Color fundus photograph from a handheld portable camera. 2212x1659: 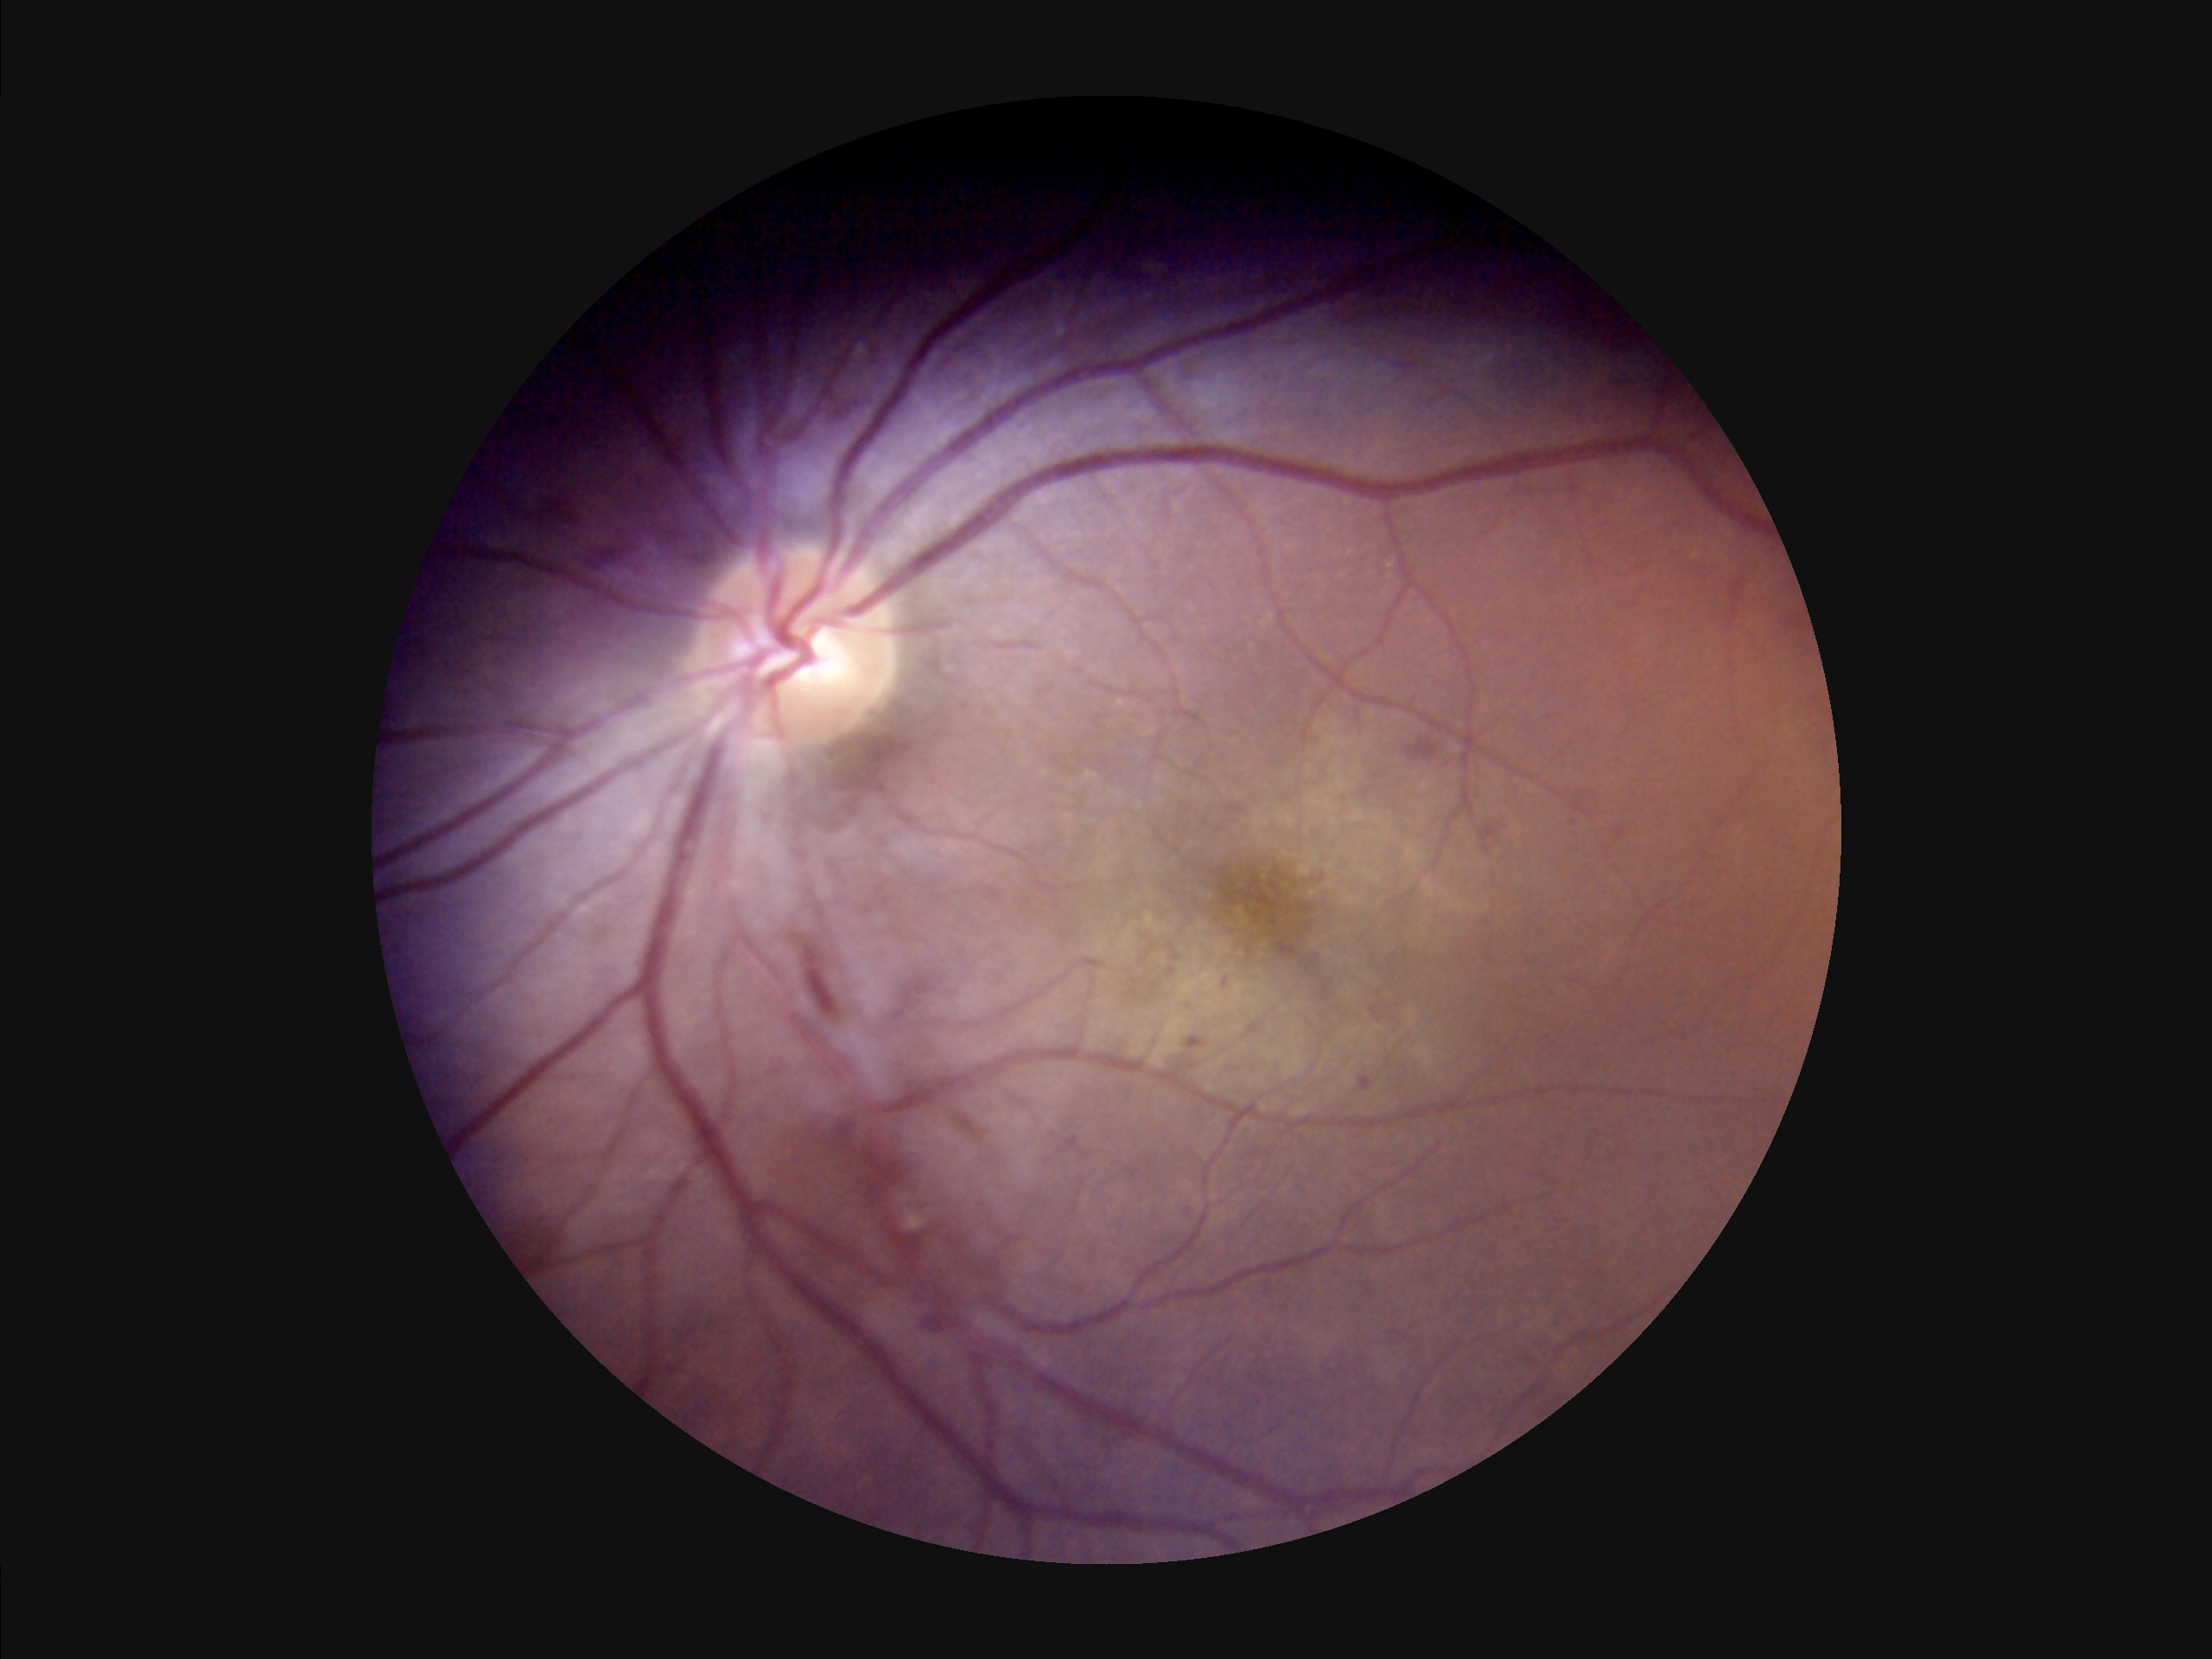
Poor illumination with uneven exposure.
Poor dynamic range.
Optic disc, vessels, and background are in focus.
Image quality is suboptimal.